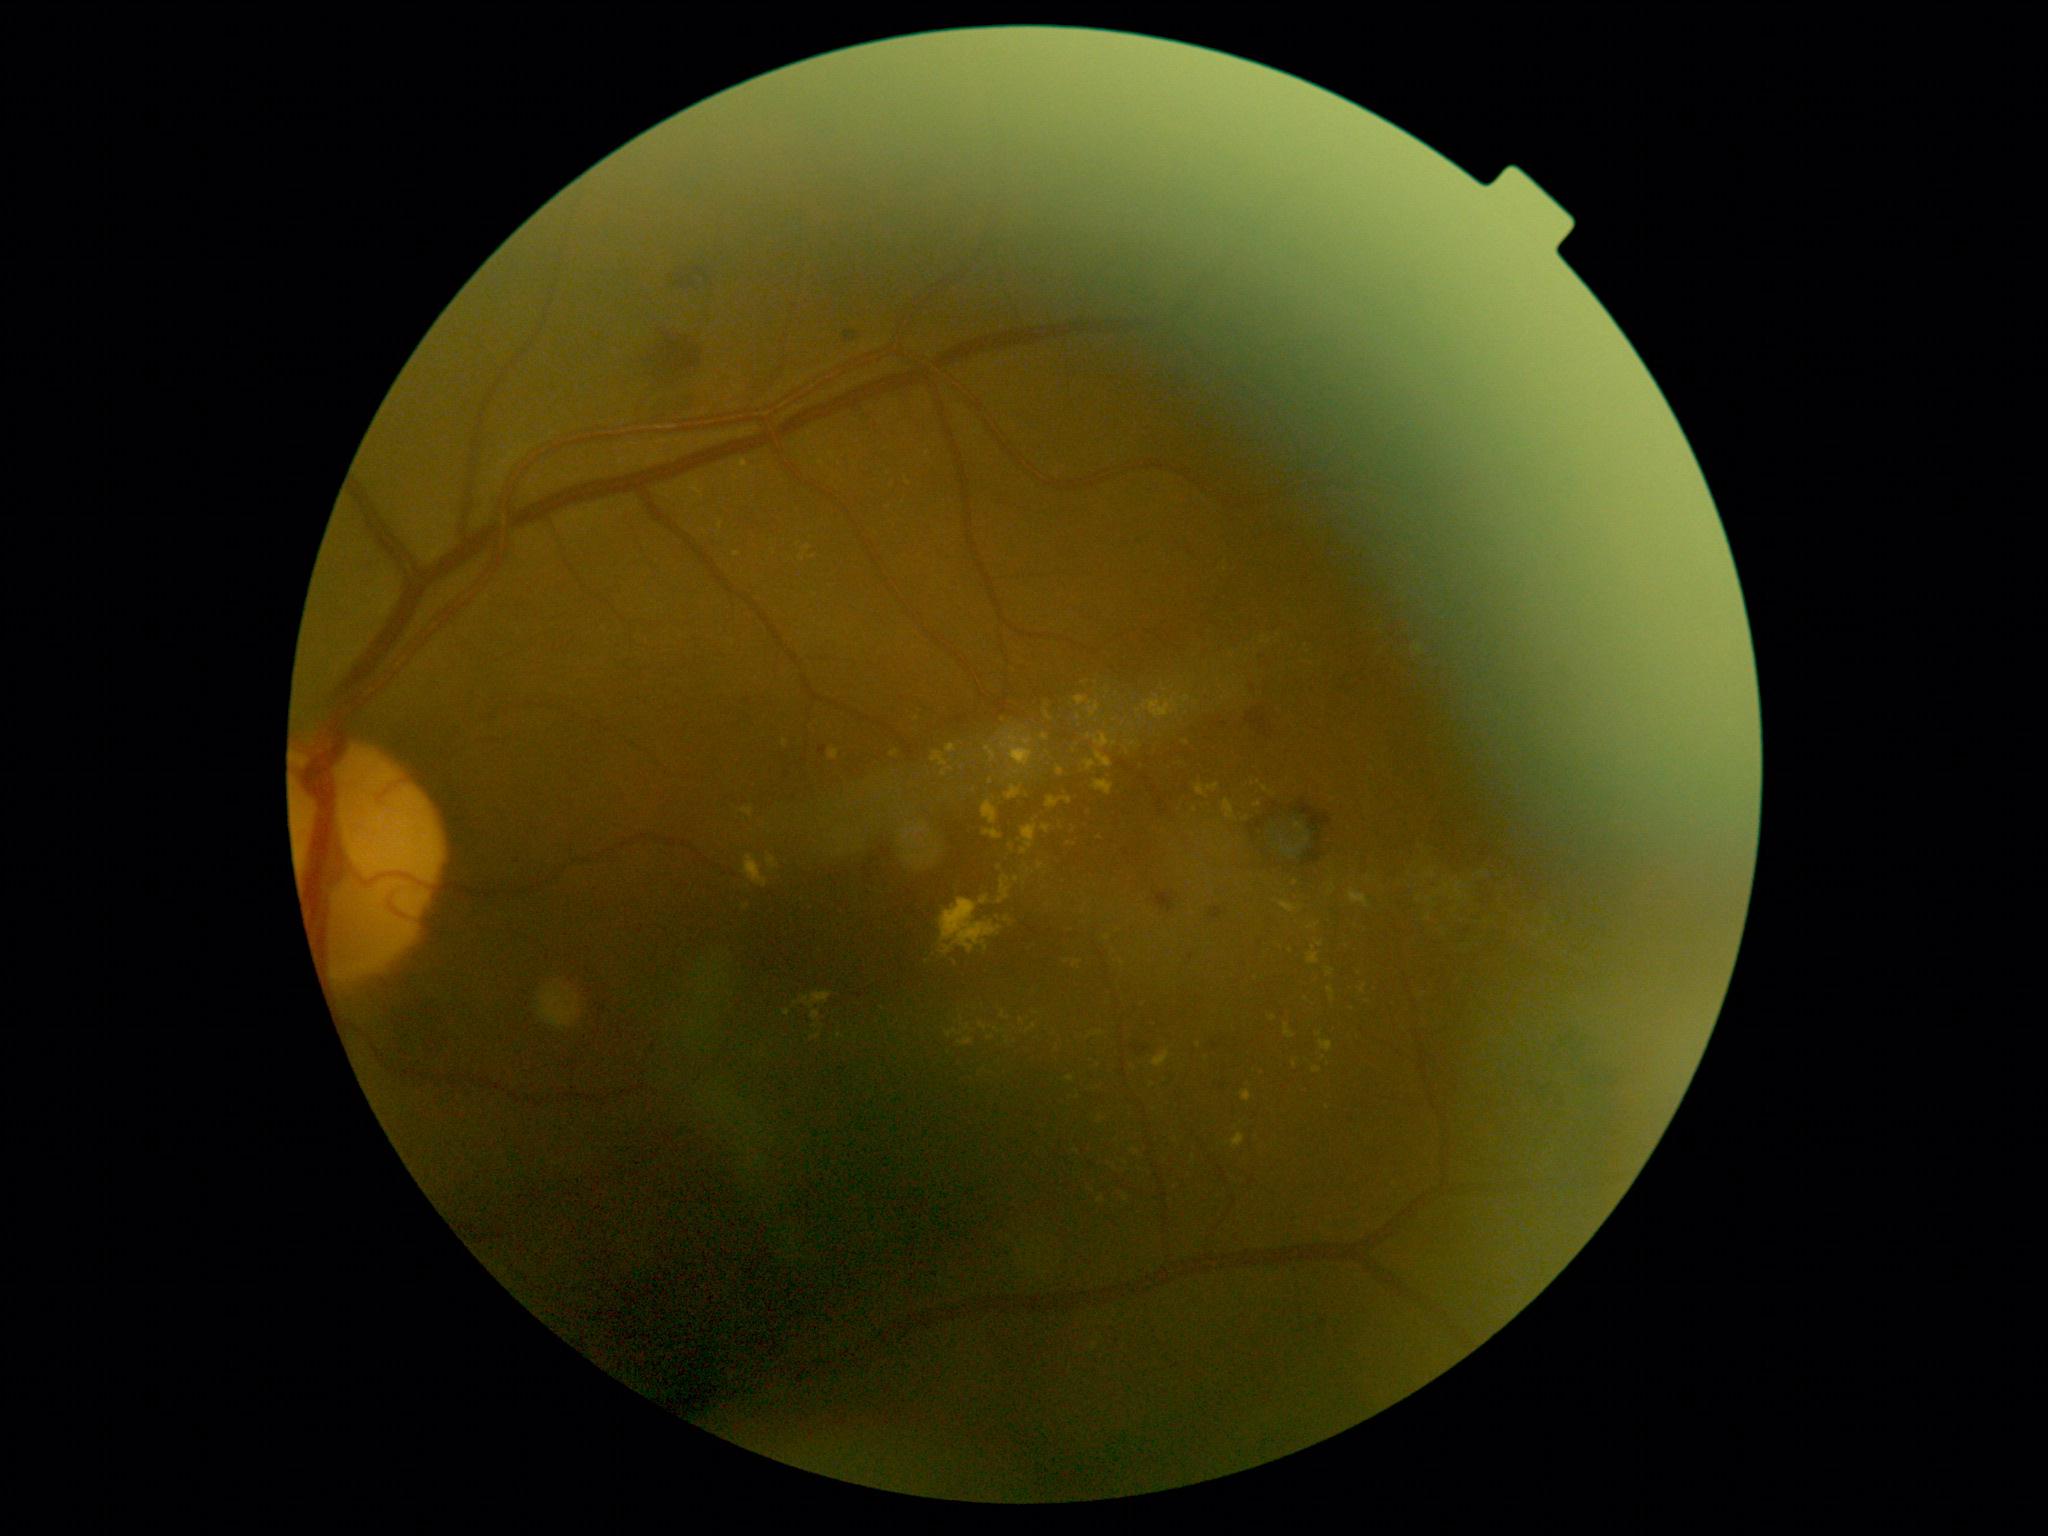

DR severity: 2/4
Selected lesions:
EXs (more not shown): region(1263, 787, 1274, 794); region(1047, 797, 1073, 809); region(986, 746, 998, 764); region(1196, 785, 1208, 798); region(1131, 1149, 1139, 1155); region(947, 745, 957, 754); region(1360, 985, 1367, 994); region(1208, 784, 1221, 793); region(902, 822, 928, 850)
Small EXs near (1273; 1018); (1070; 1079); (1187; 743); (1368; 1002); (1100; 838); (797; 1004); (1295; 1065); (951; 769); (1123; 964)